1470x1137px, fundus photo:
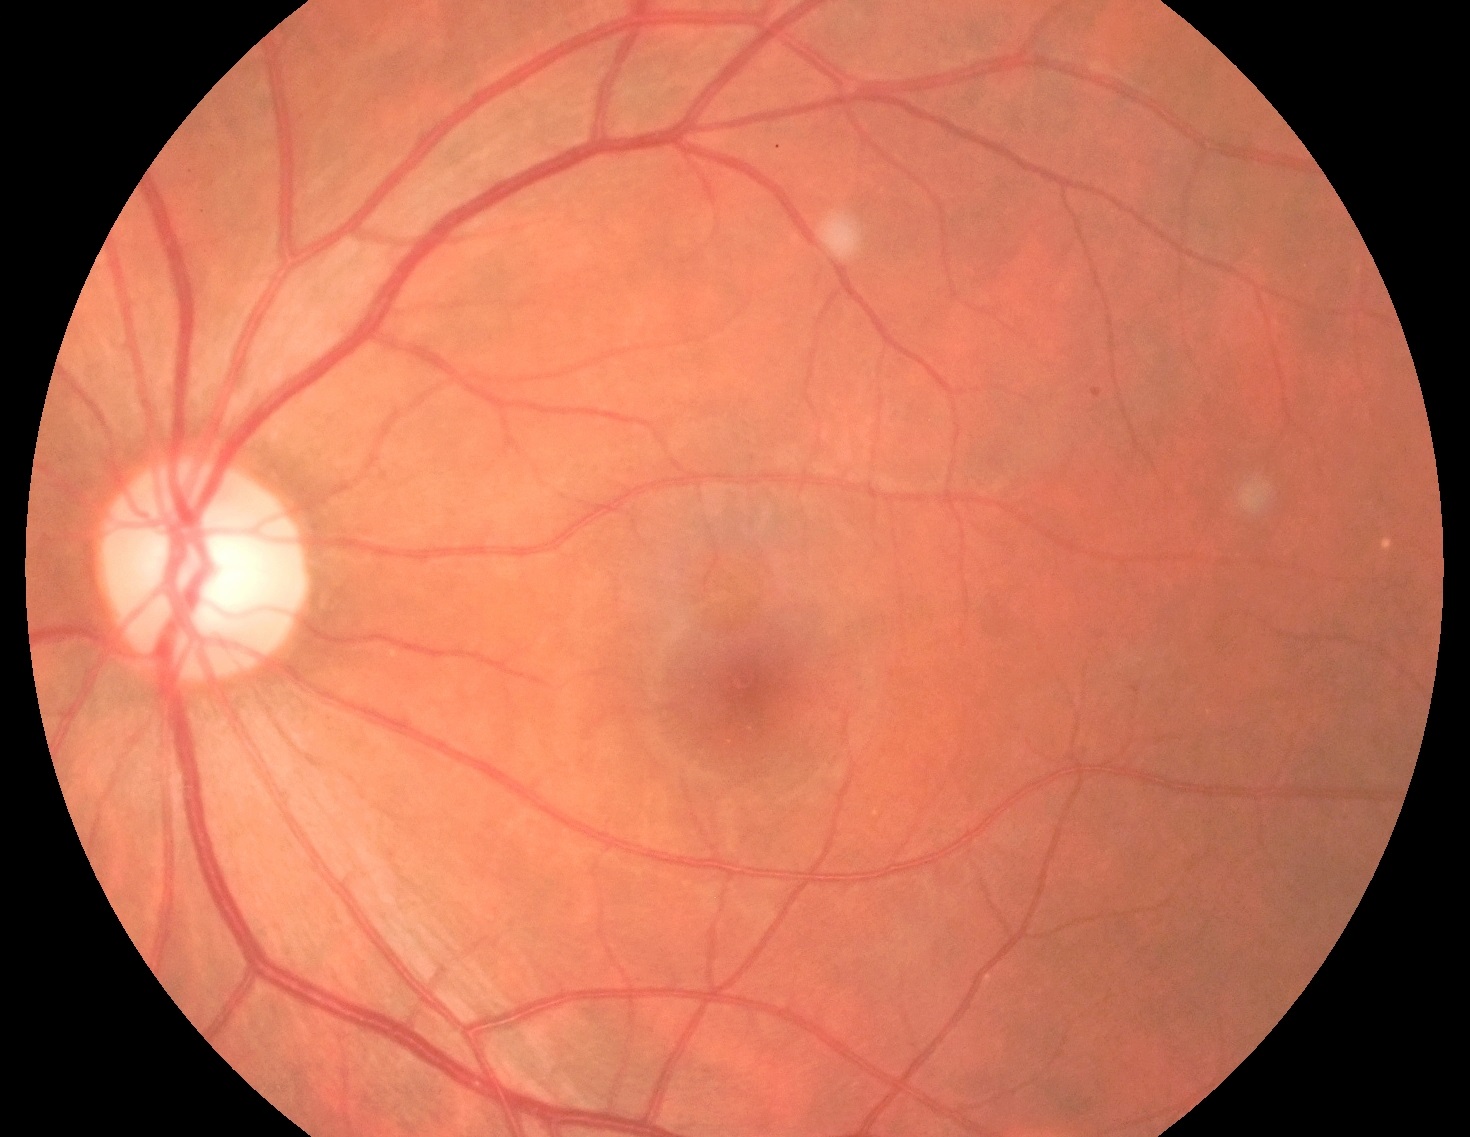
DR severity: mild NPDR (grade 1).